Nonmydriatic, modified Davis grading, posterior pole photograph:
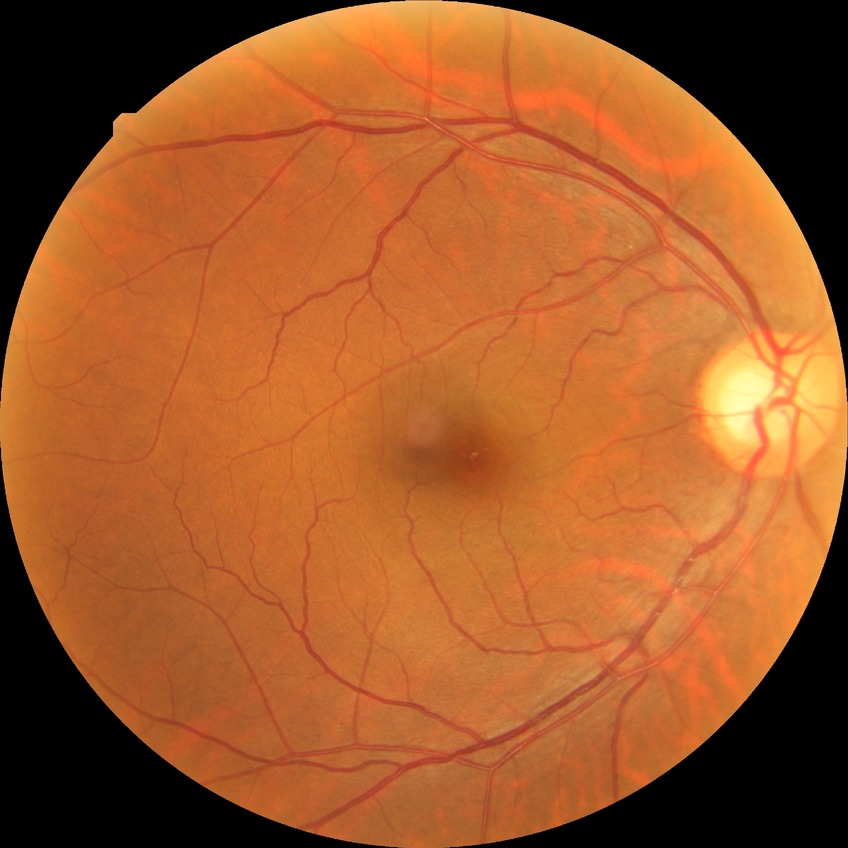
Diabetic retinopathy (DR) is no diabetic retinopathy (NDR).